FOV: 45 degrees — 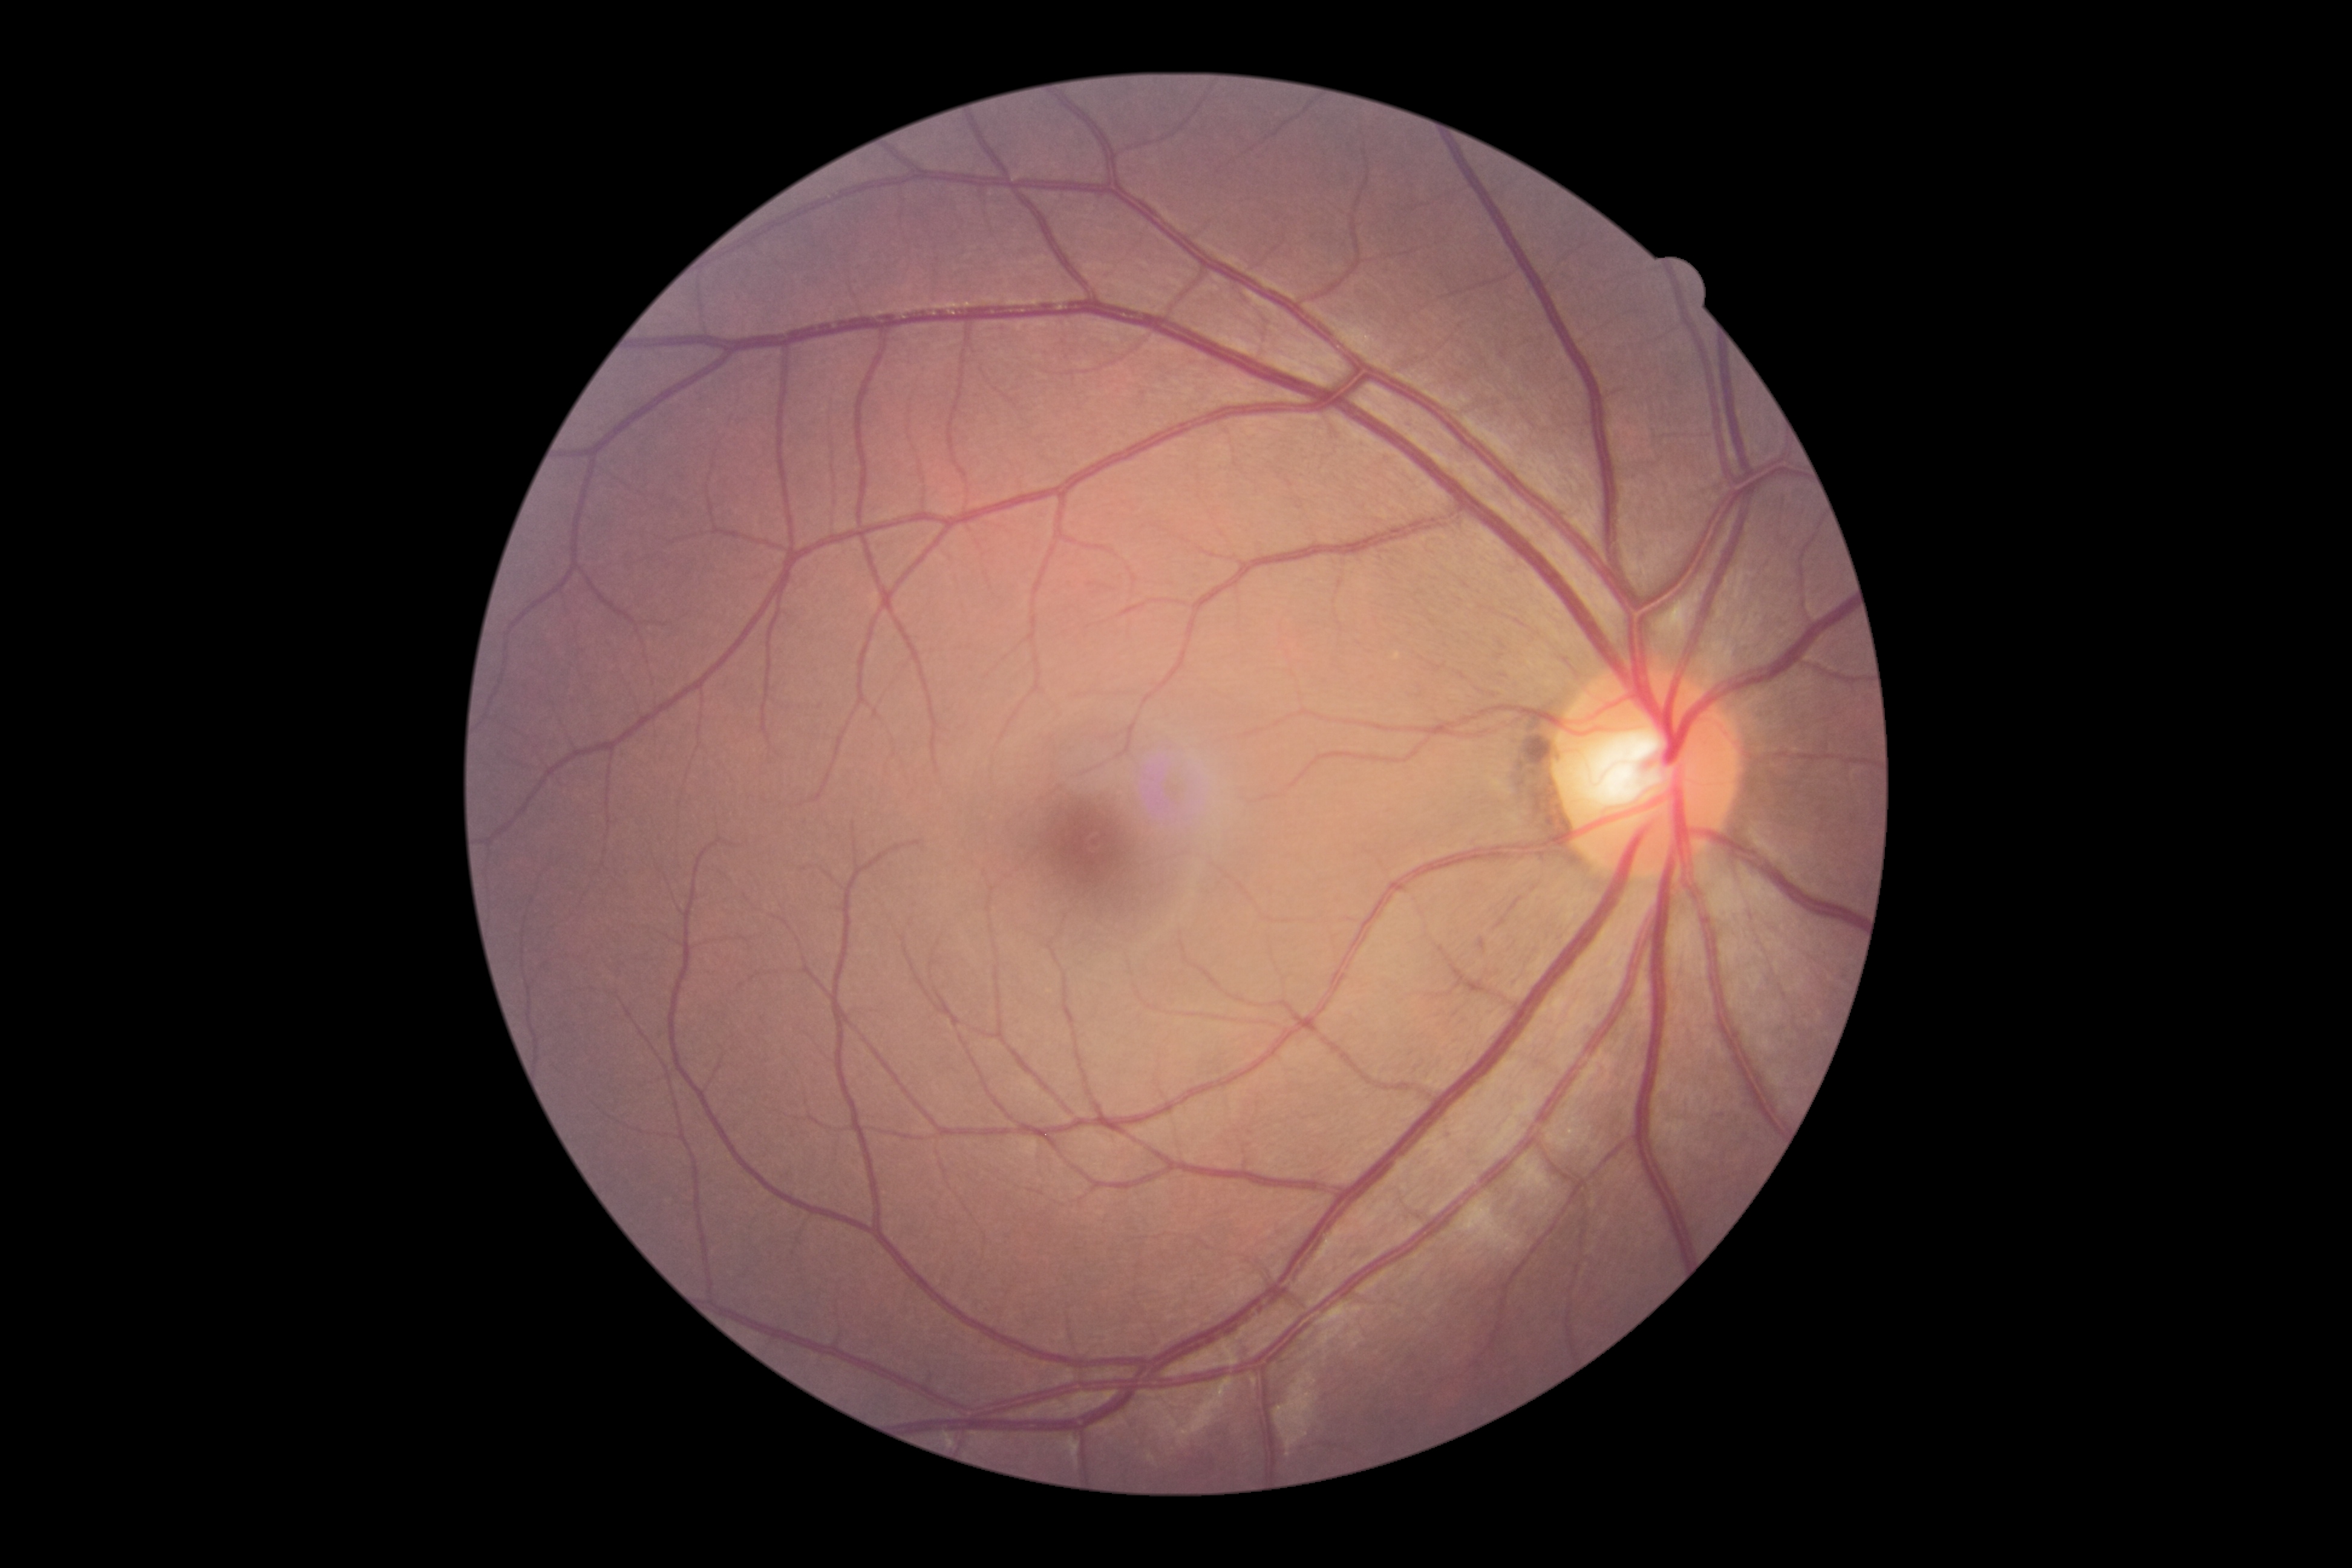 retinopathy = grade 0.